Acquired with a NIDEK AFC-230 · fundus photo · without pupil dilation · 848x848
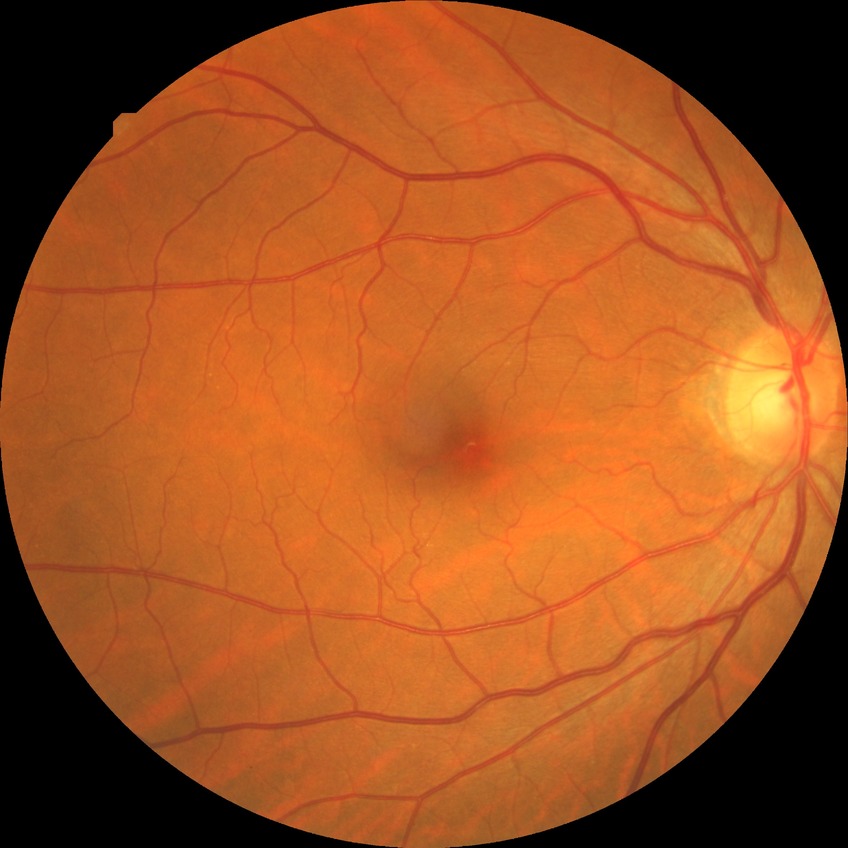 DR is NDR.
No diabetic retinal disease findings.